2352x1568. 45° field of view: 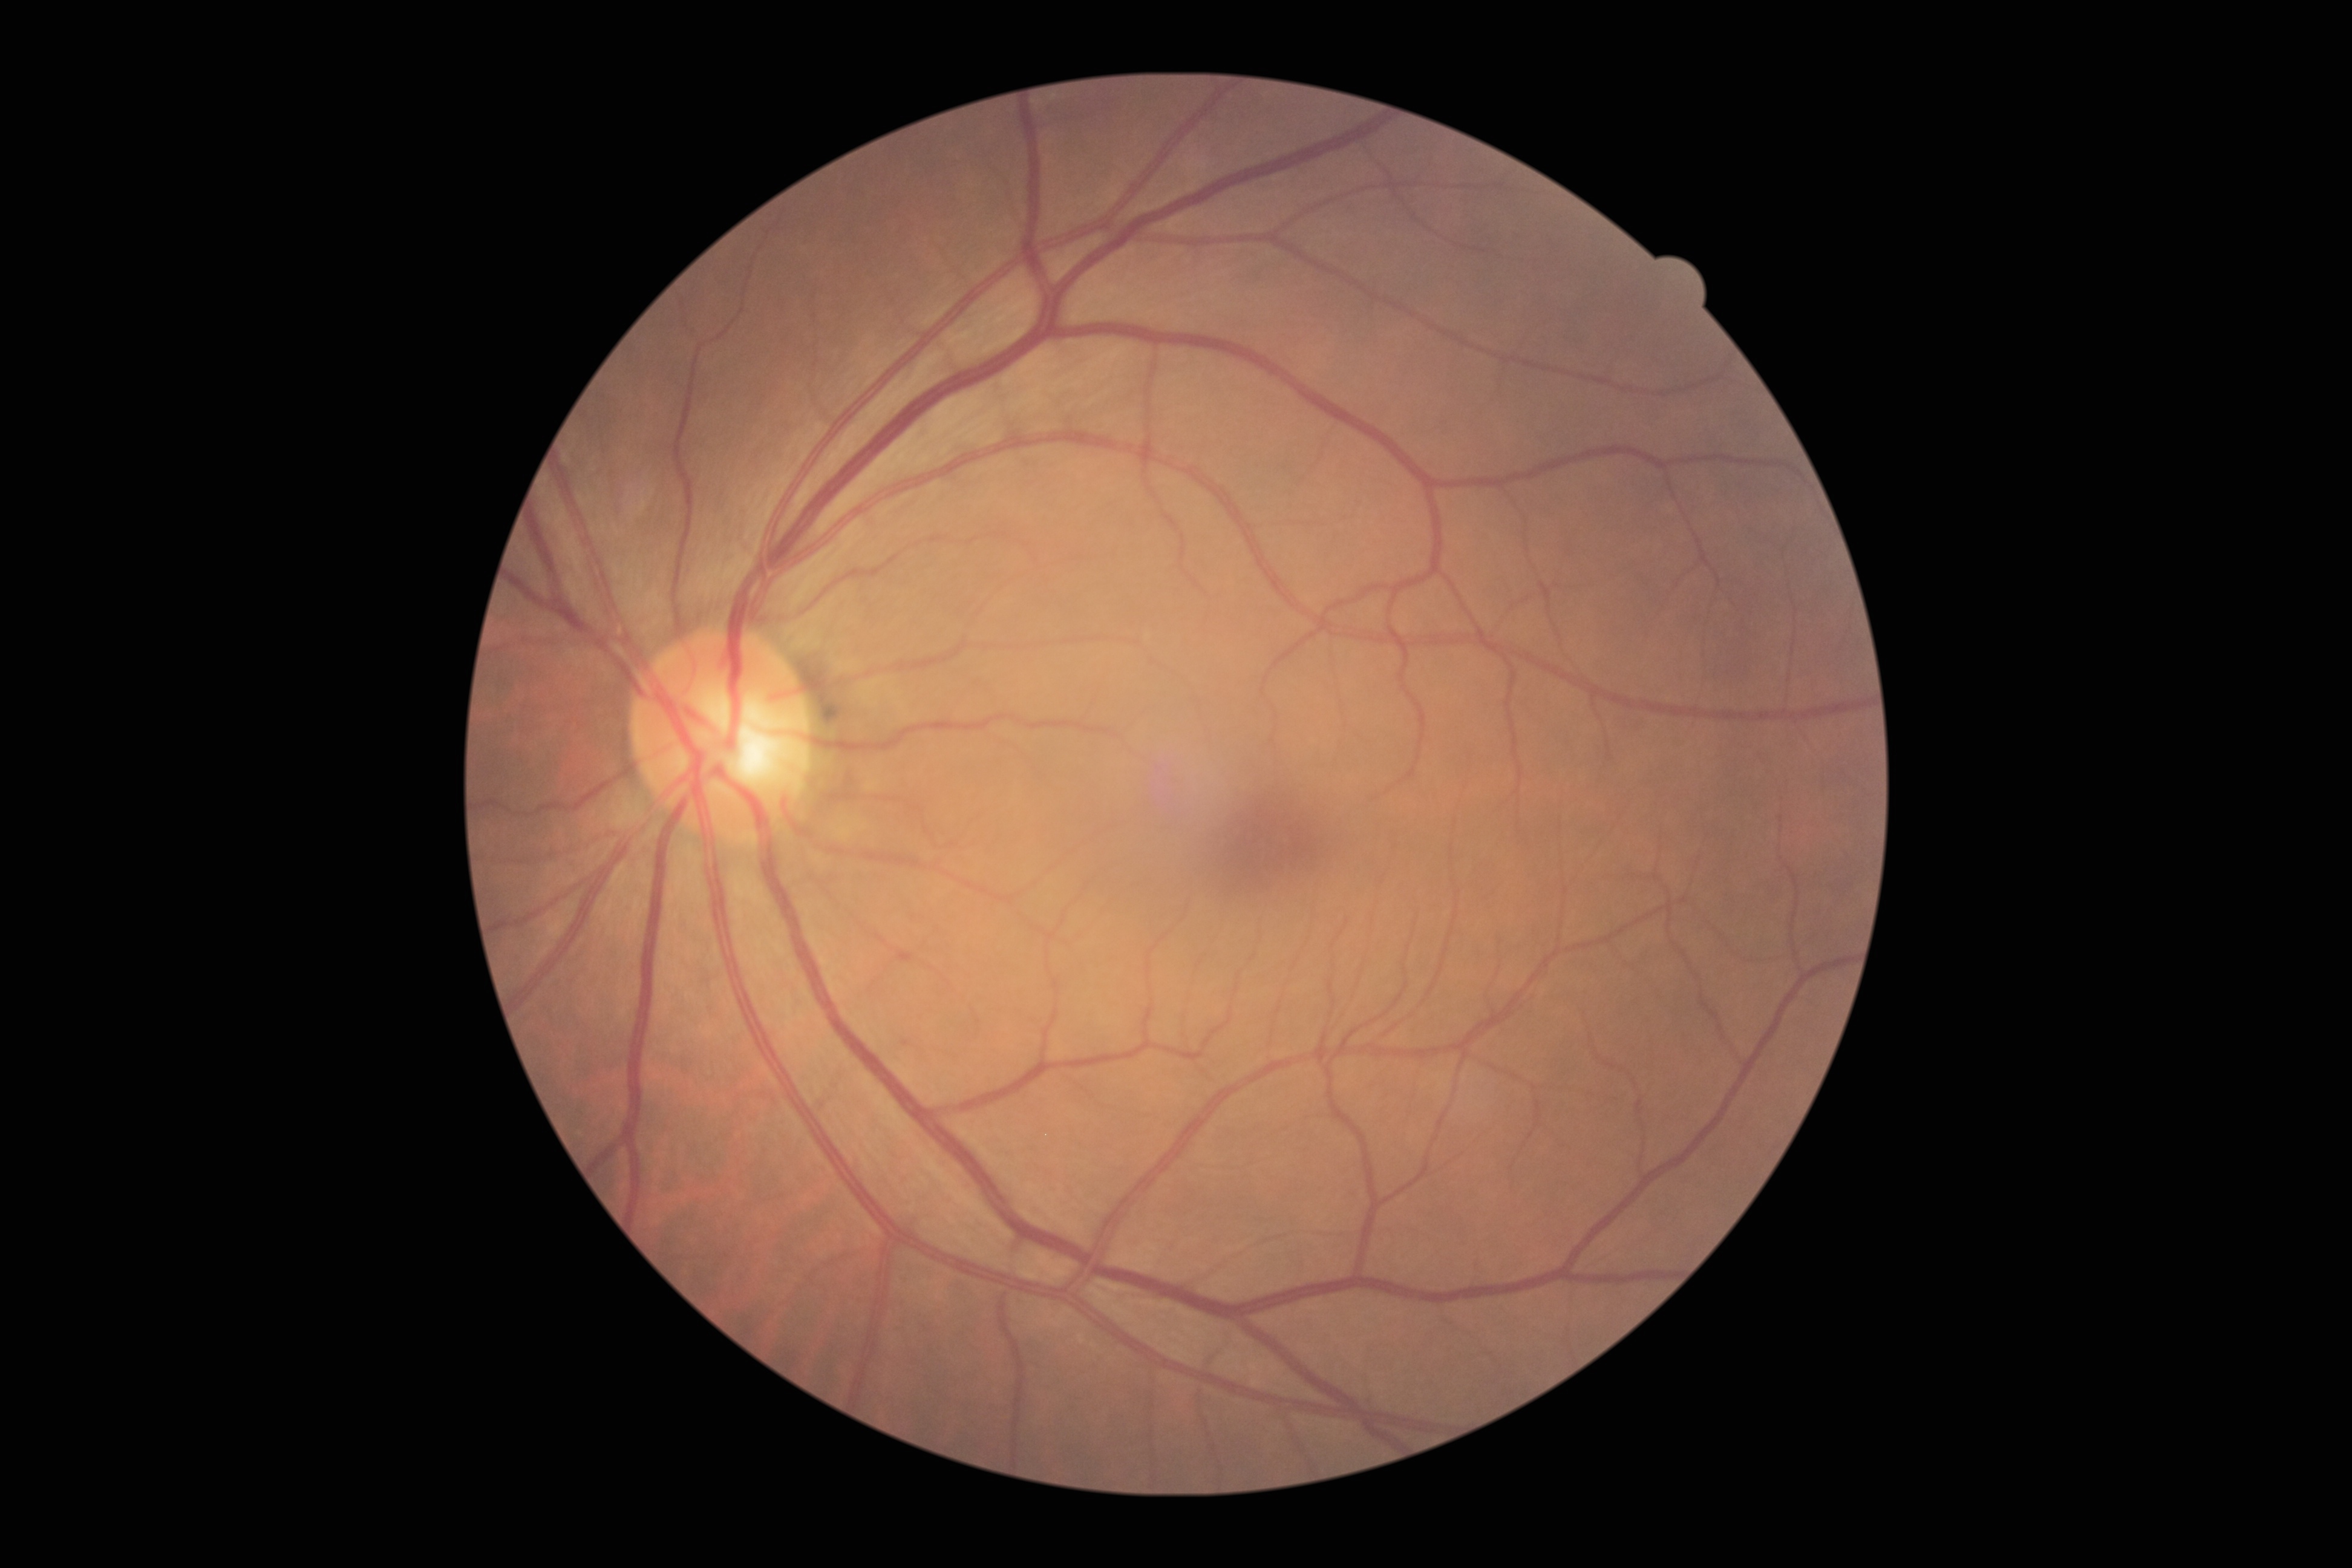
No diabetic retinal disease findings. Diabetic retinopathy grade is no apparent diabetic retinopathy (0).